Graded on the modified Davis scale — 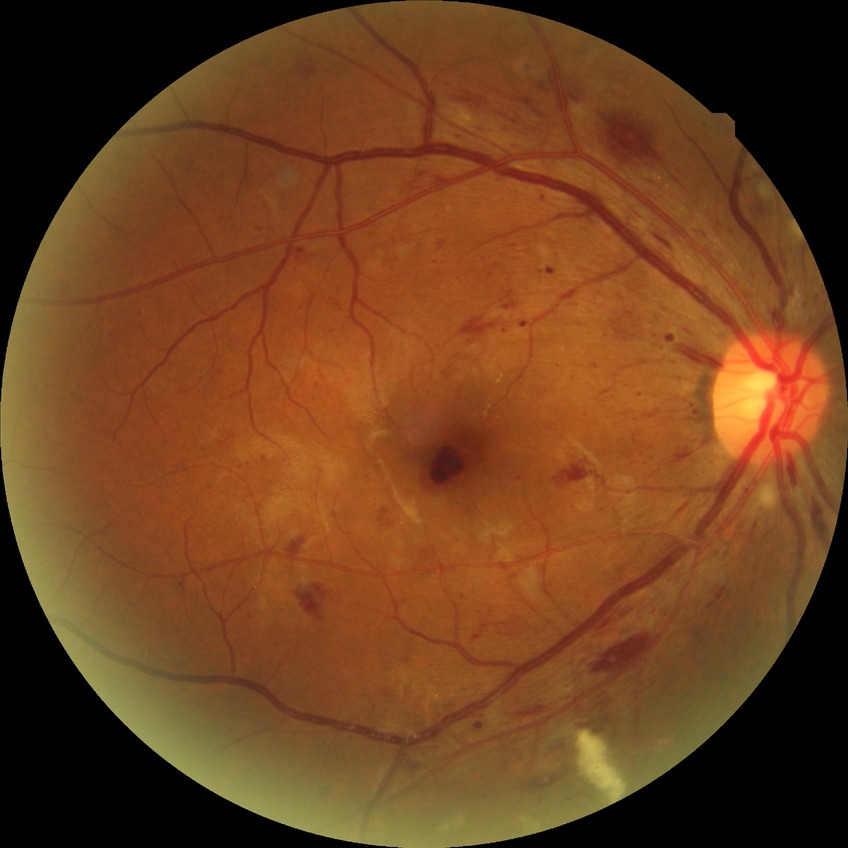 modified Davis classification = pre-proliferative diabetic retinopathy.